50° field of view:
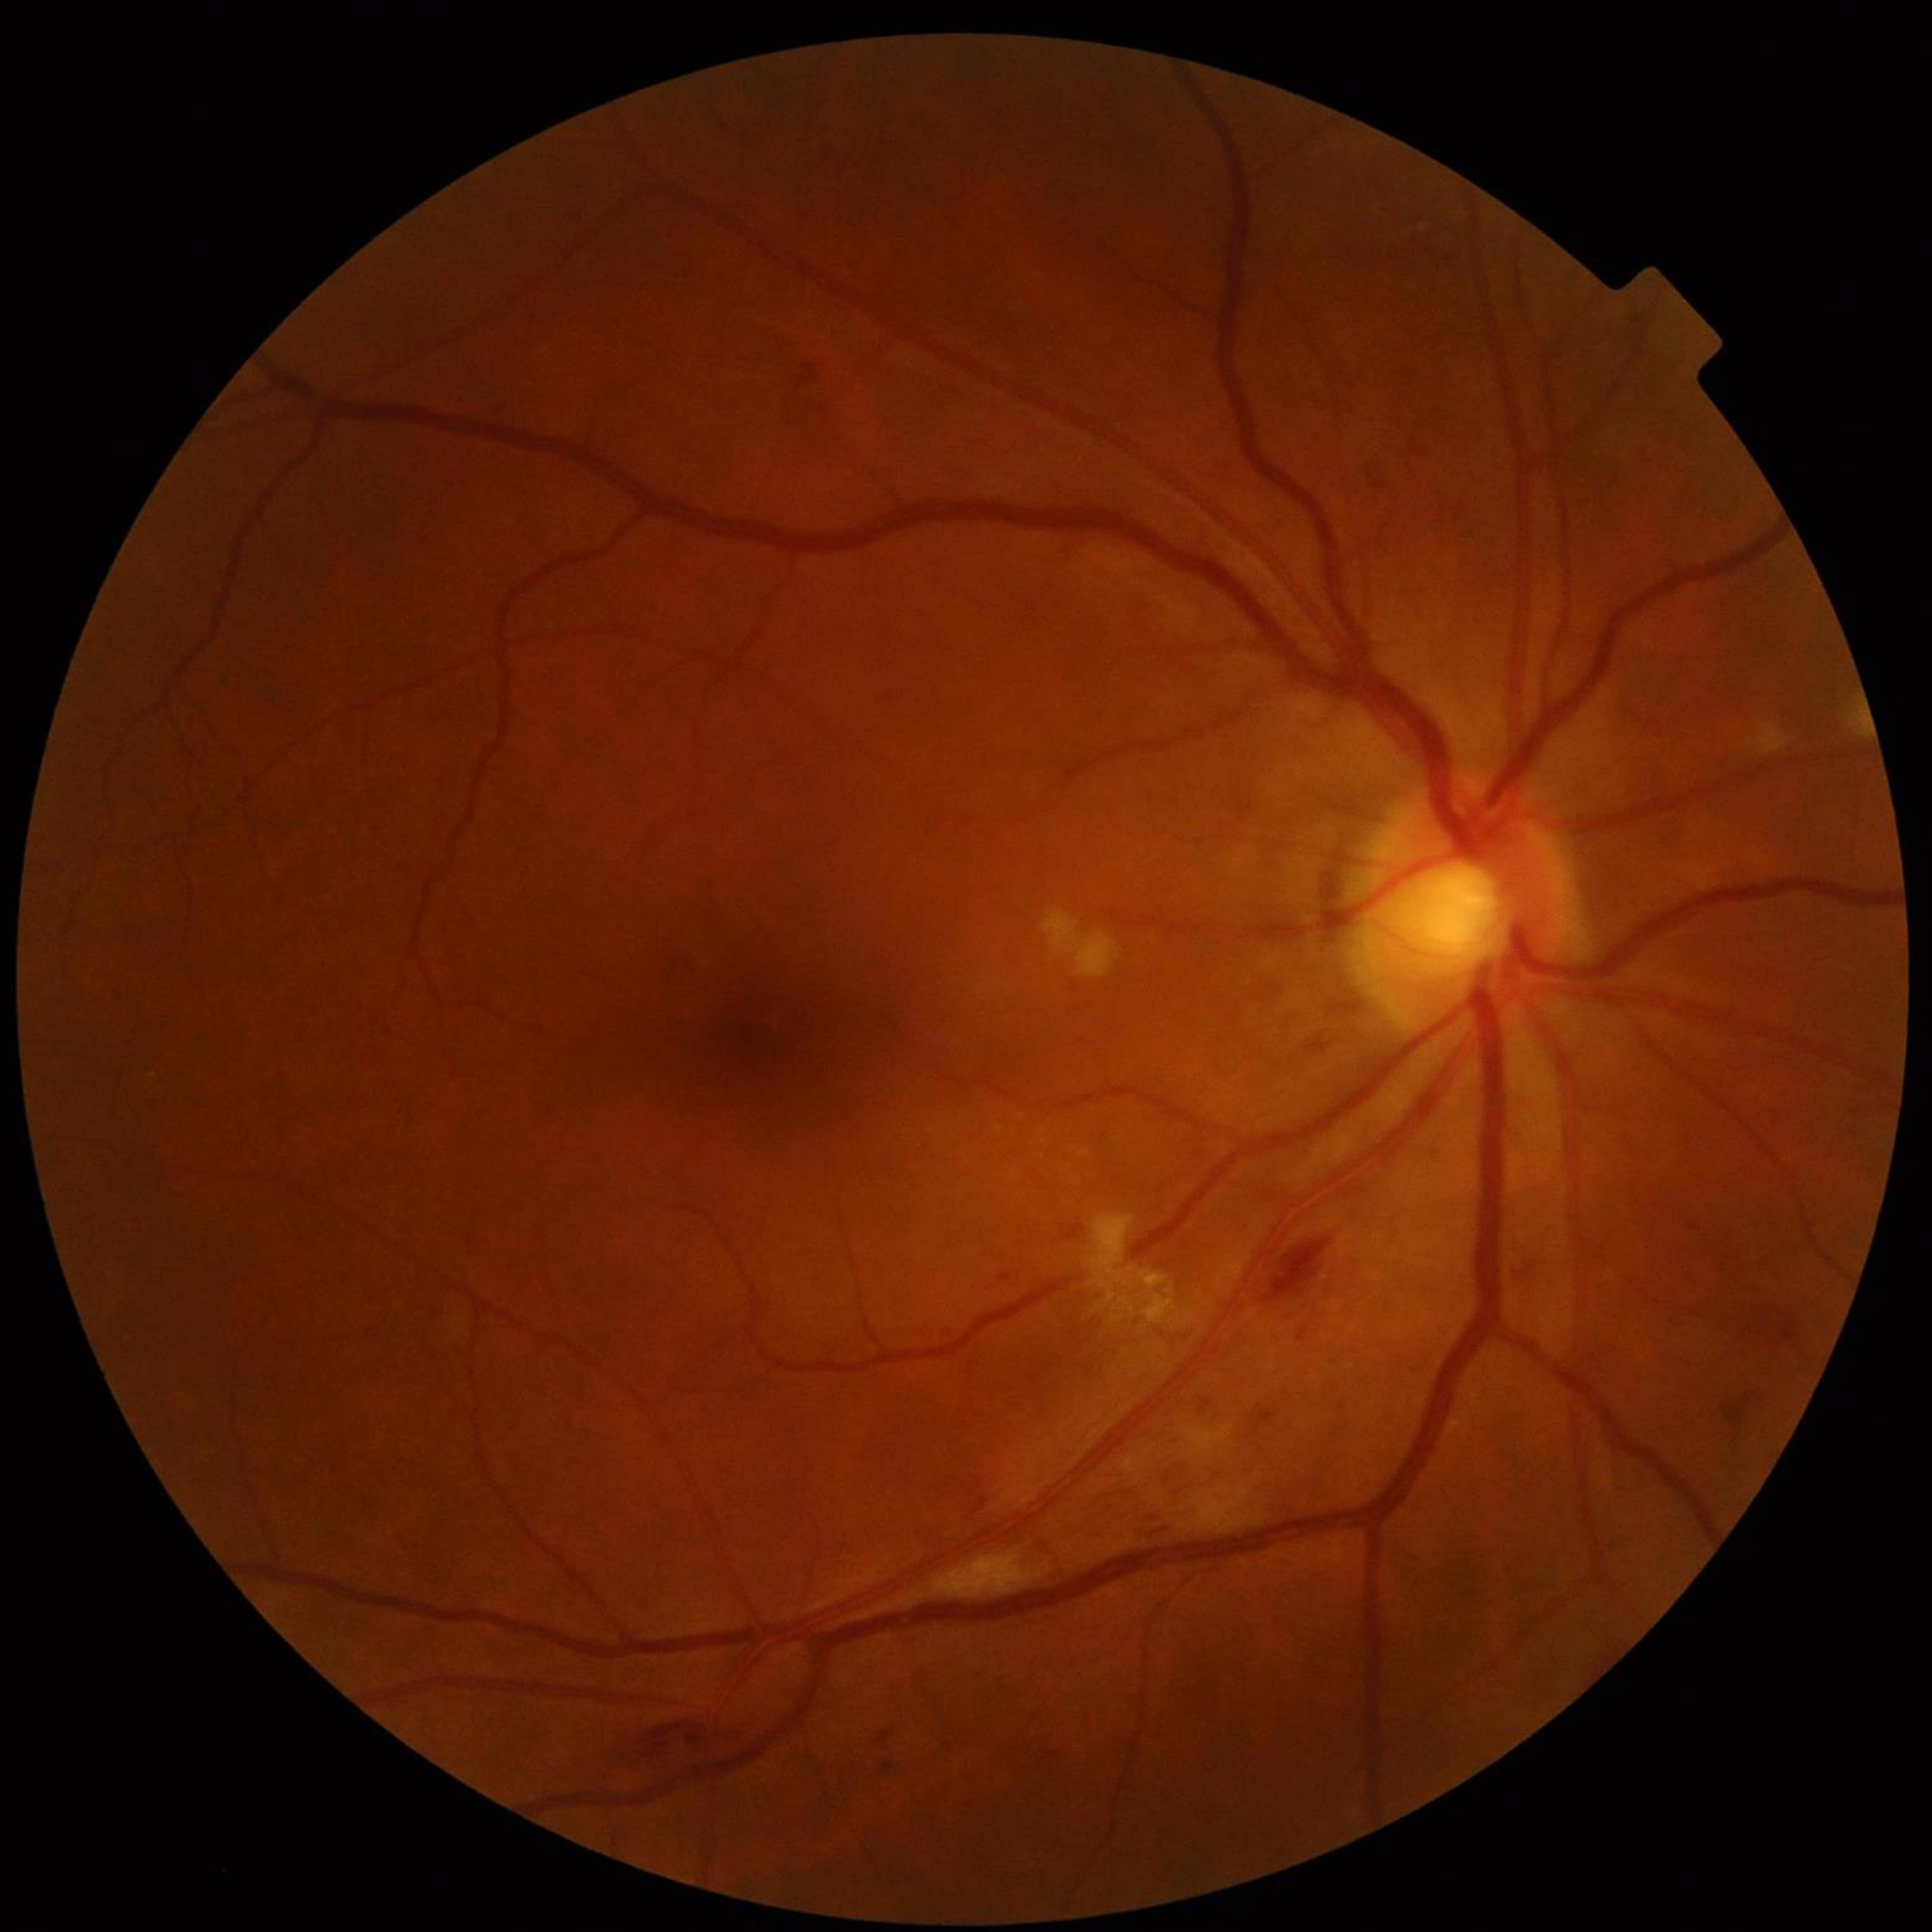
Clinical diagnosis: diabetic retinopathy (DR)
Image quality: adequate